45° field of view: 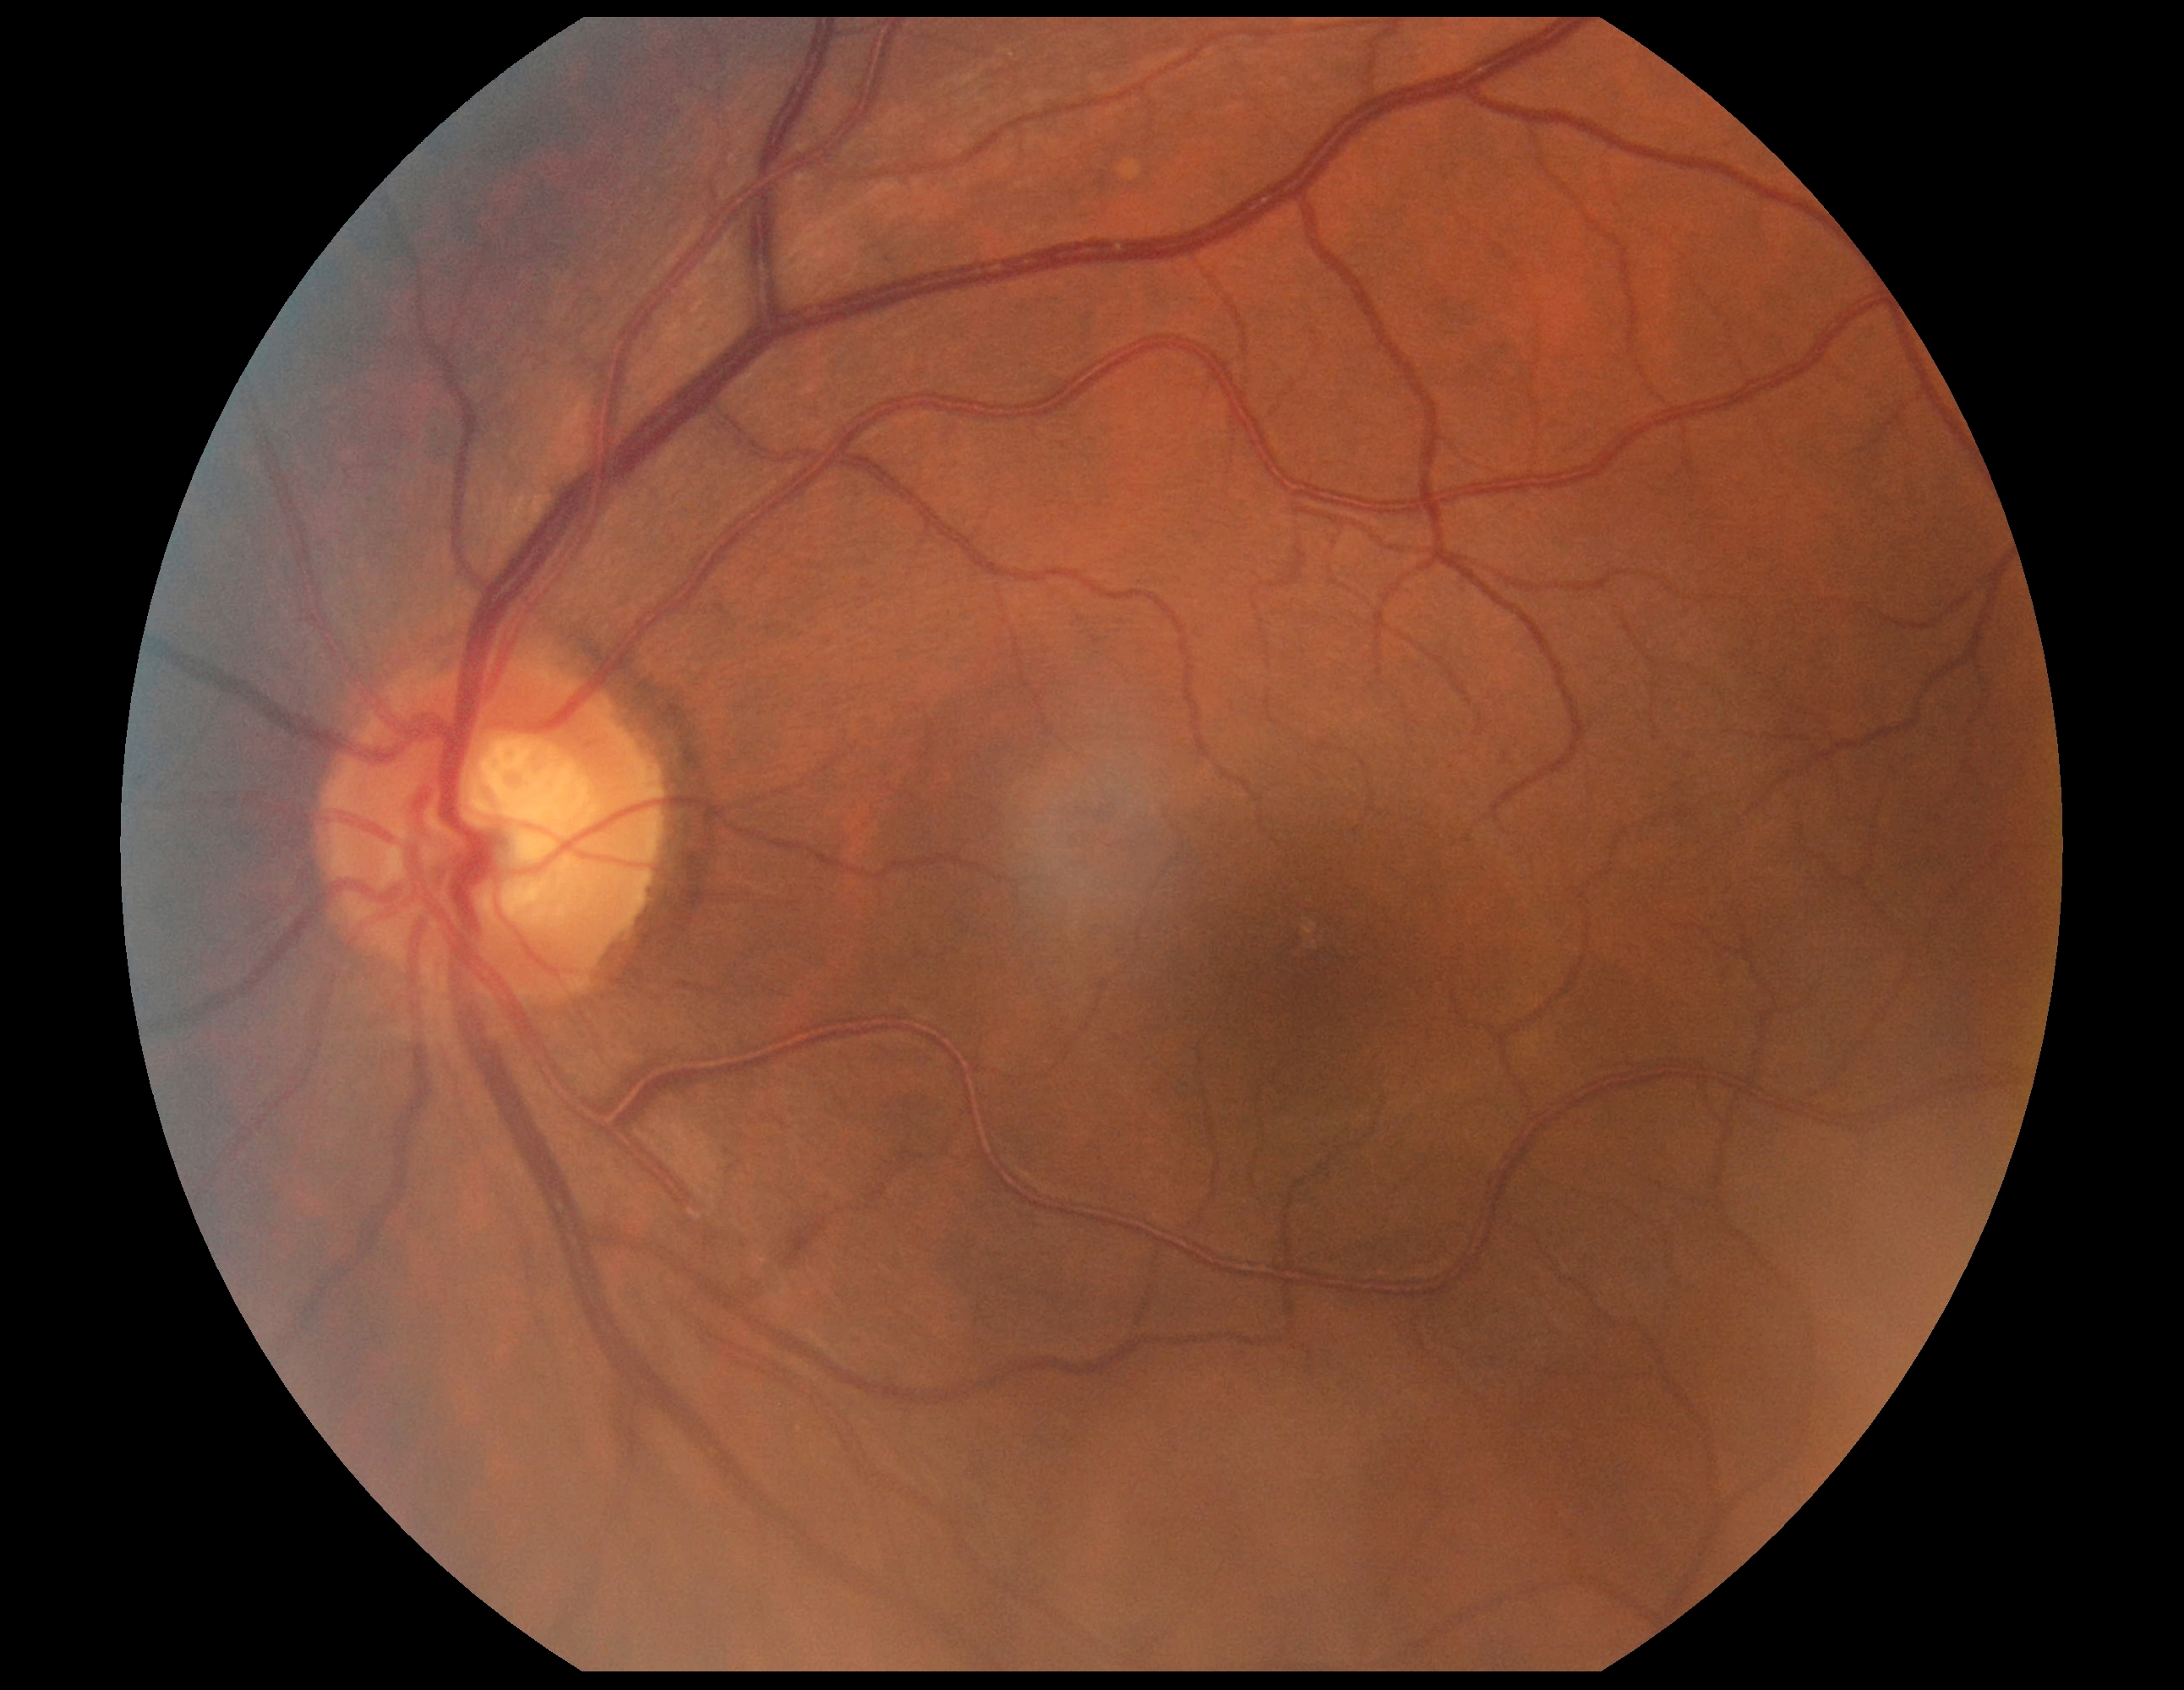
DR = grade 0
DR impression = no apparent DR